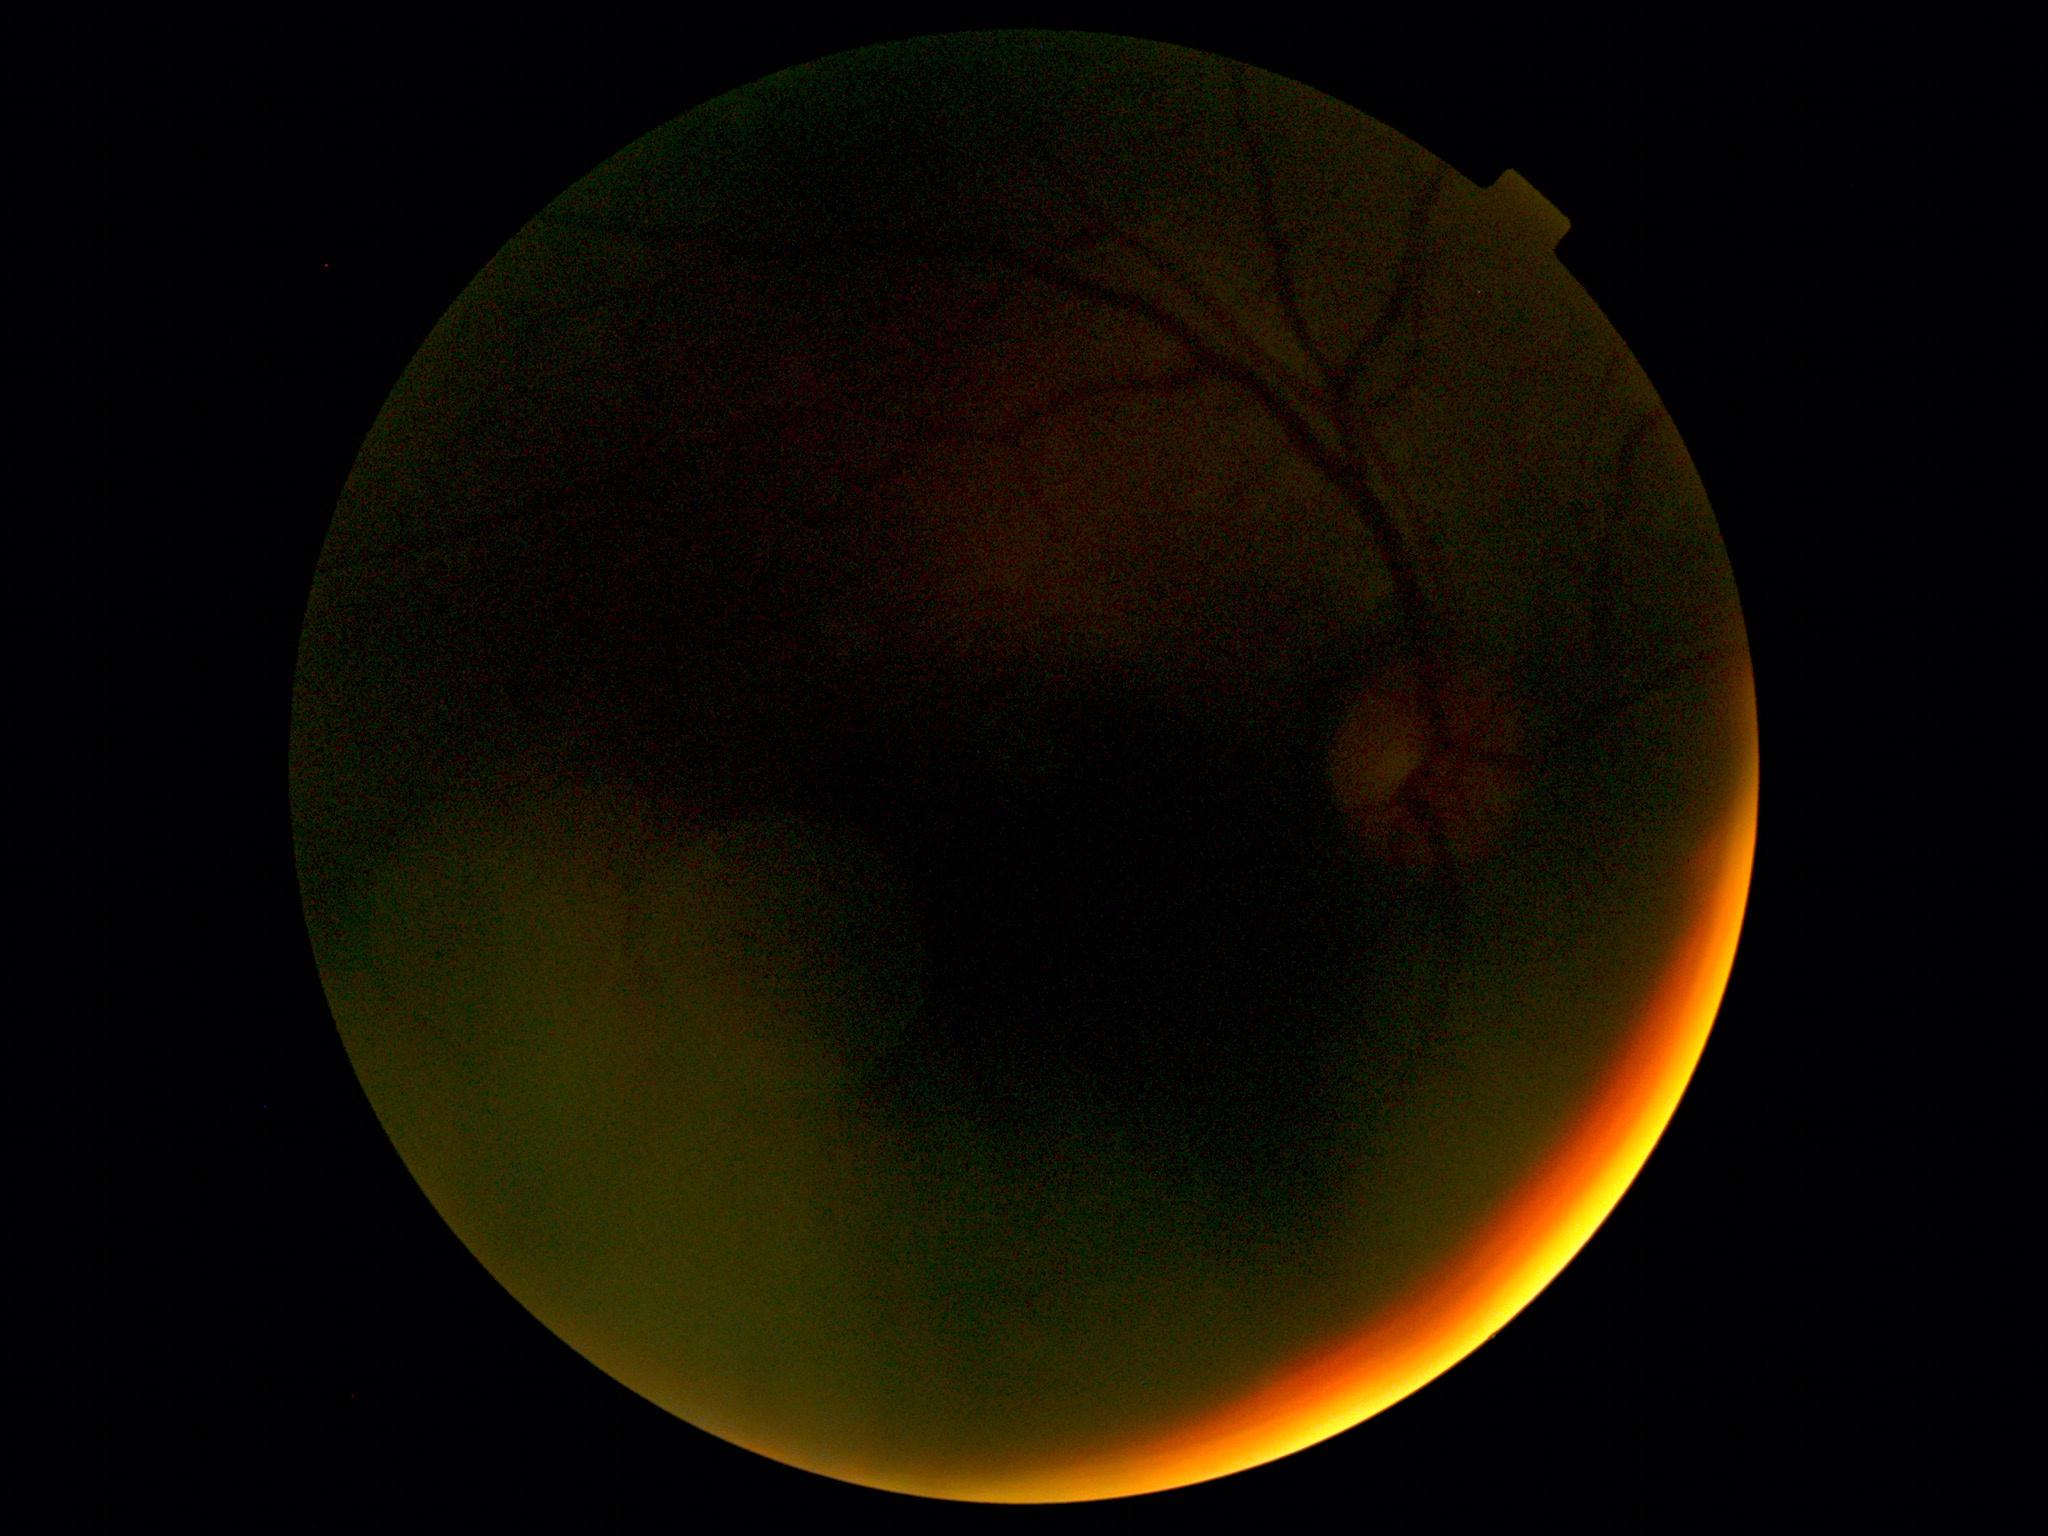 image quality=too poor for DR grading, retinopathy grade=ungradable.